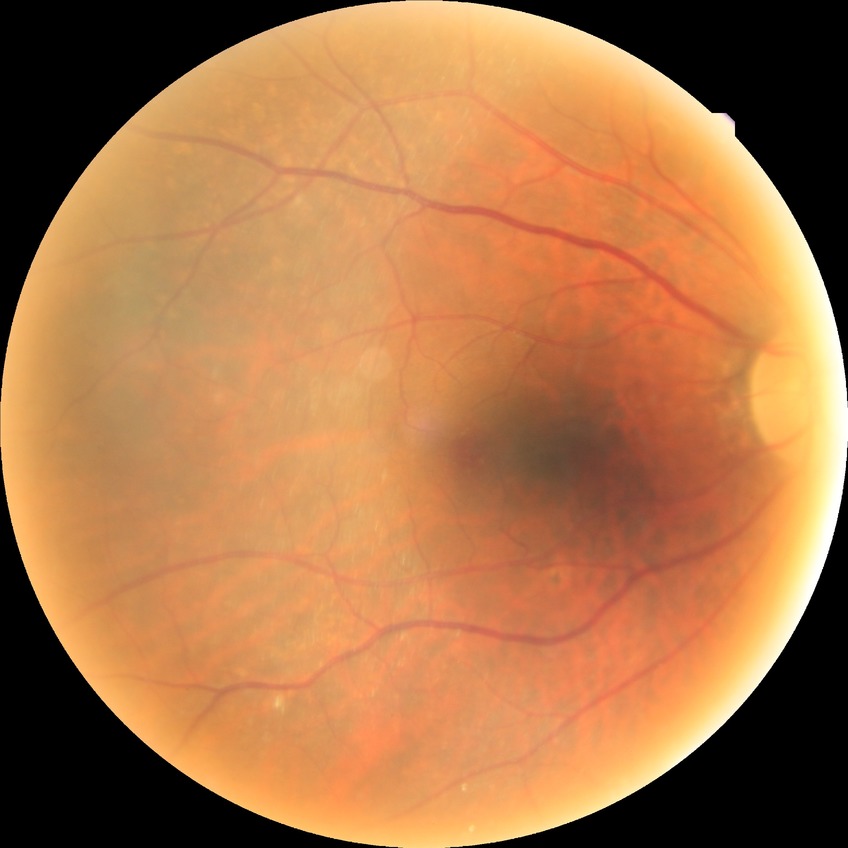

• retinopathy stage — no diabetic retinopathy